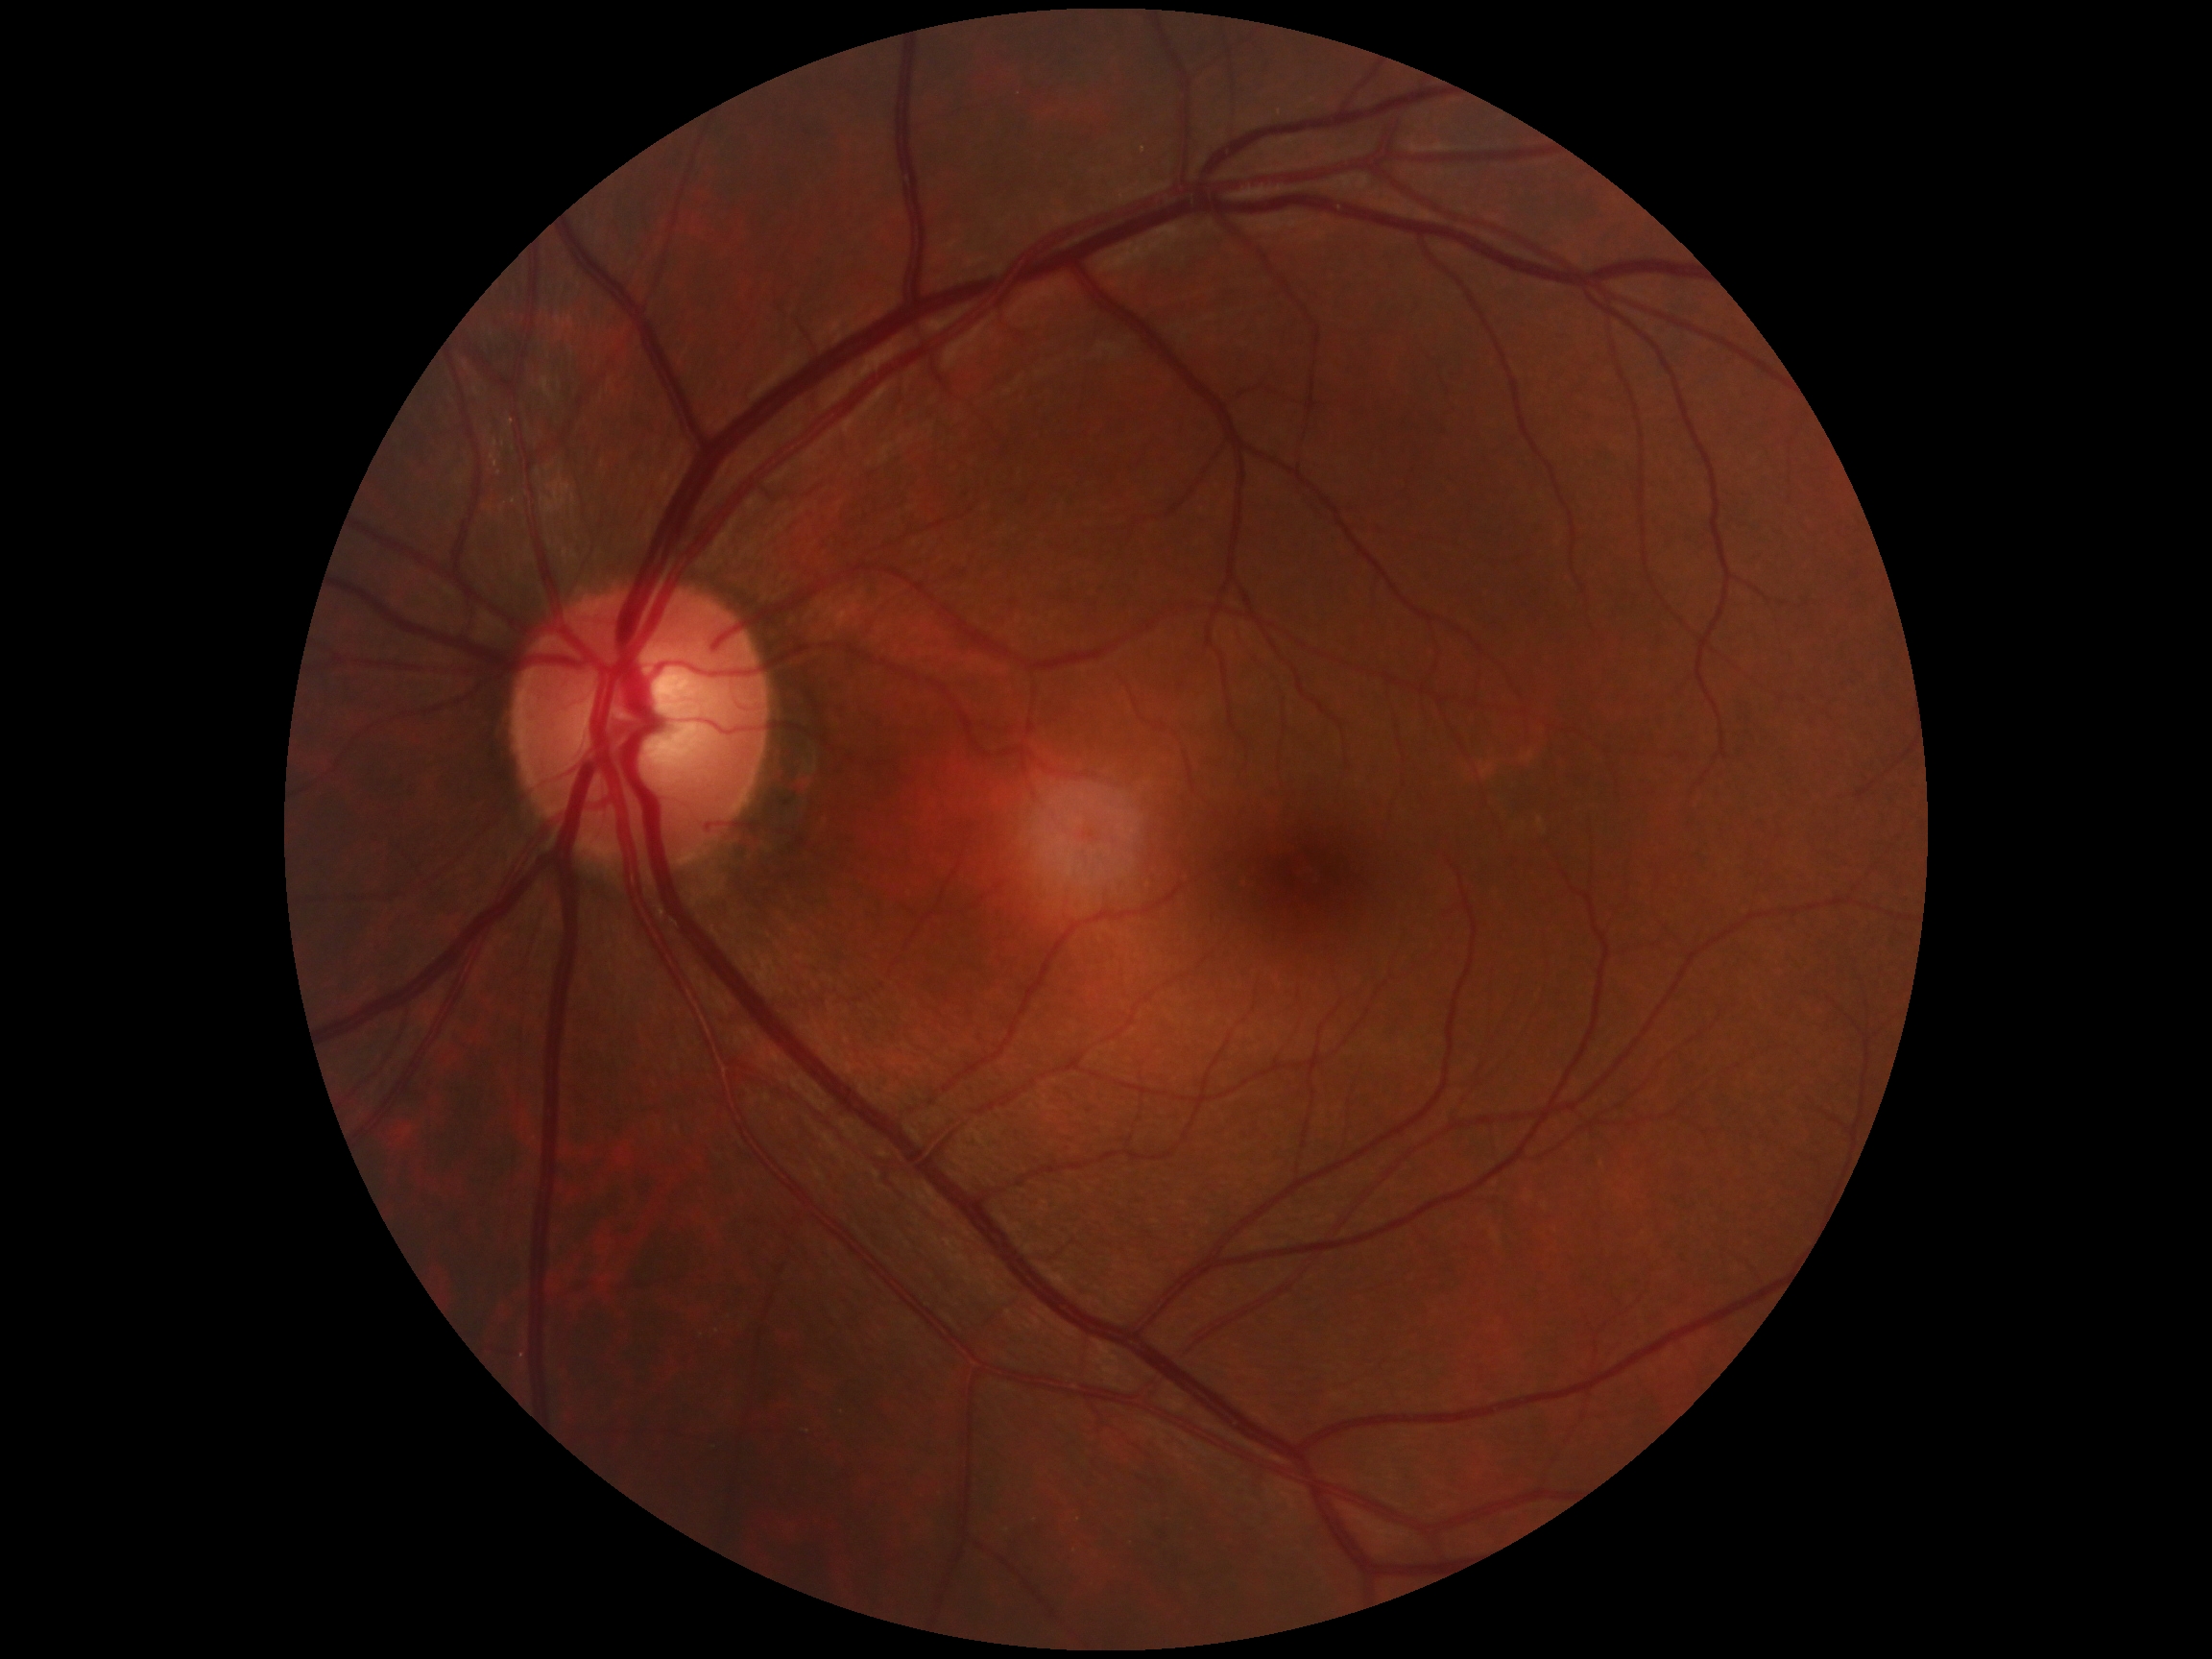 diabetic retinopathy (DR) = grade 0 (no apparent retinopathy)